2368x1568; color fundus photograph
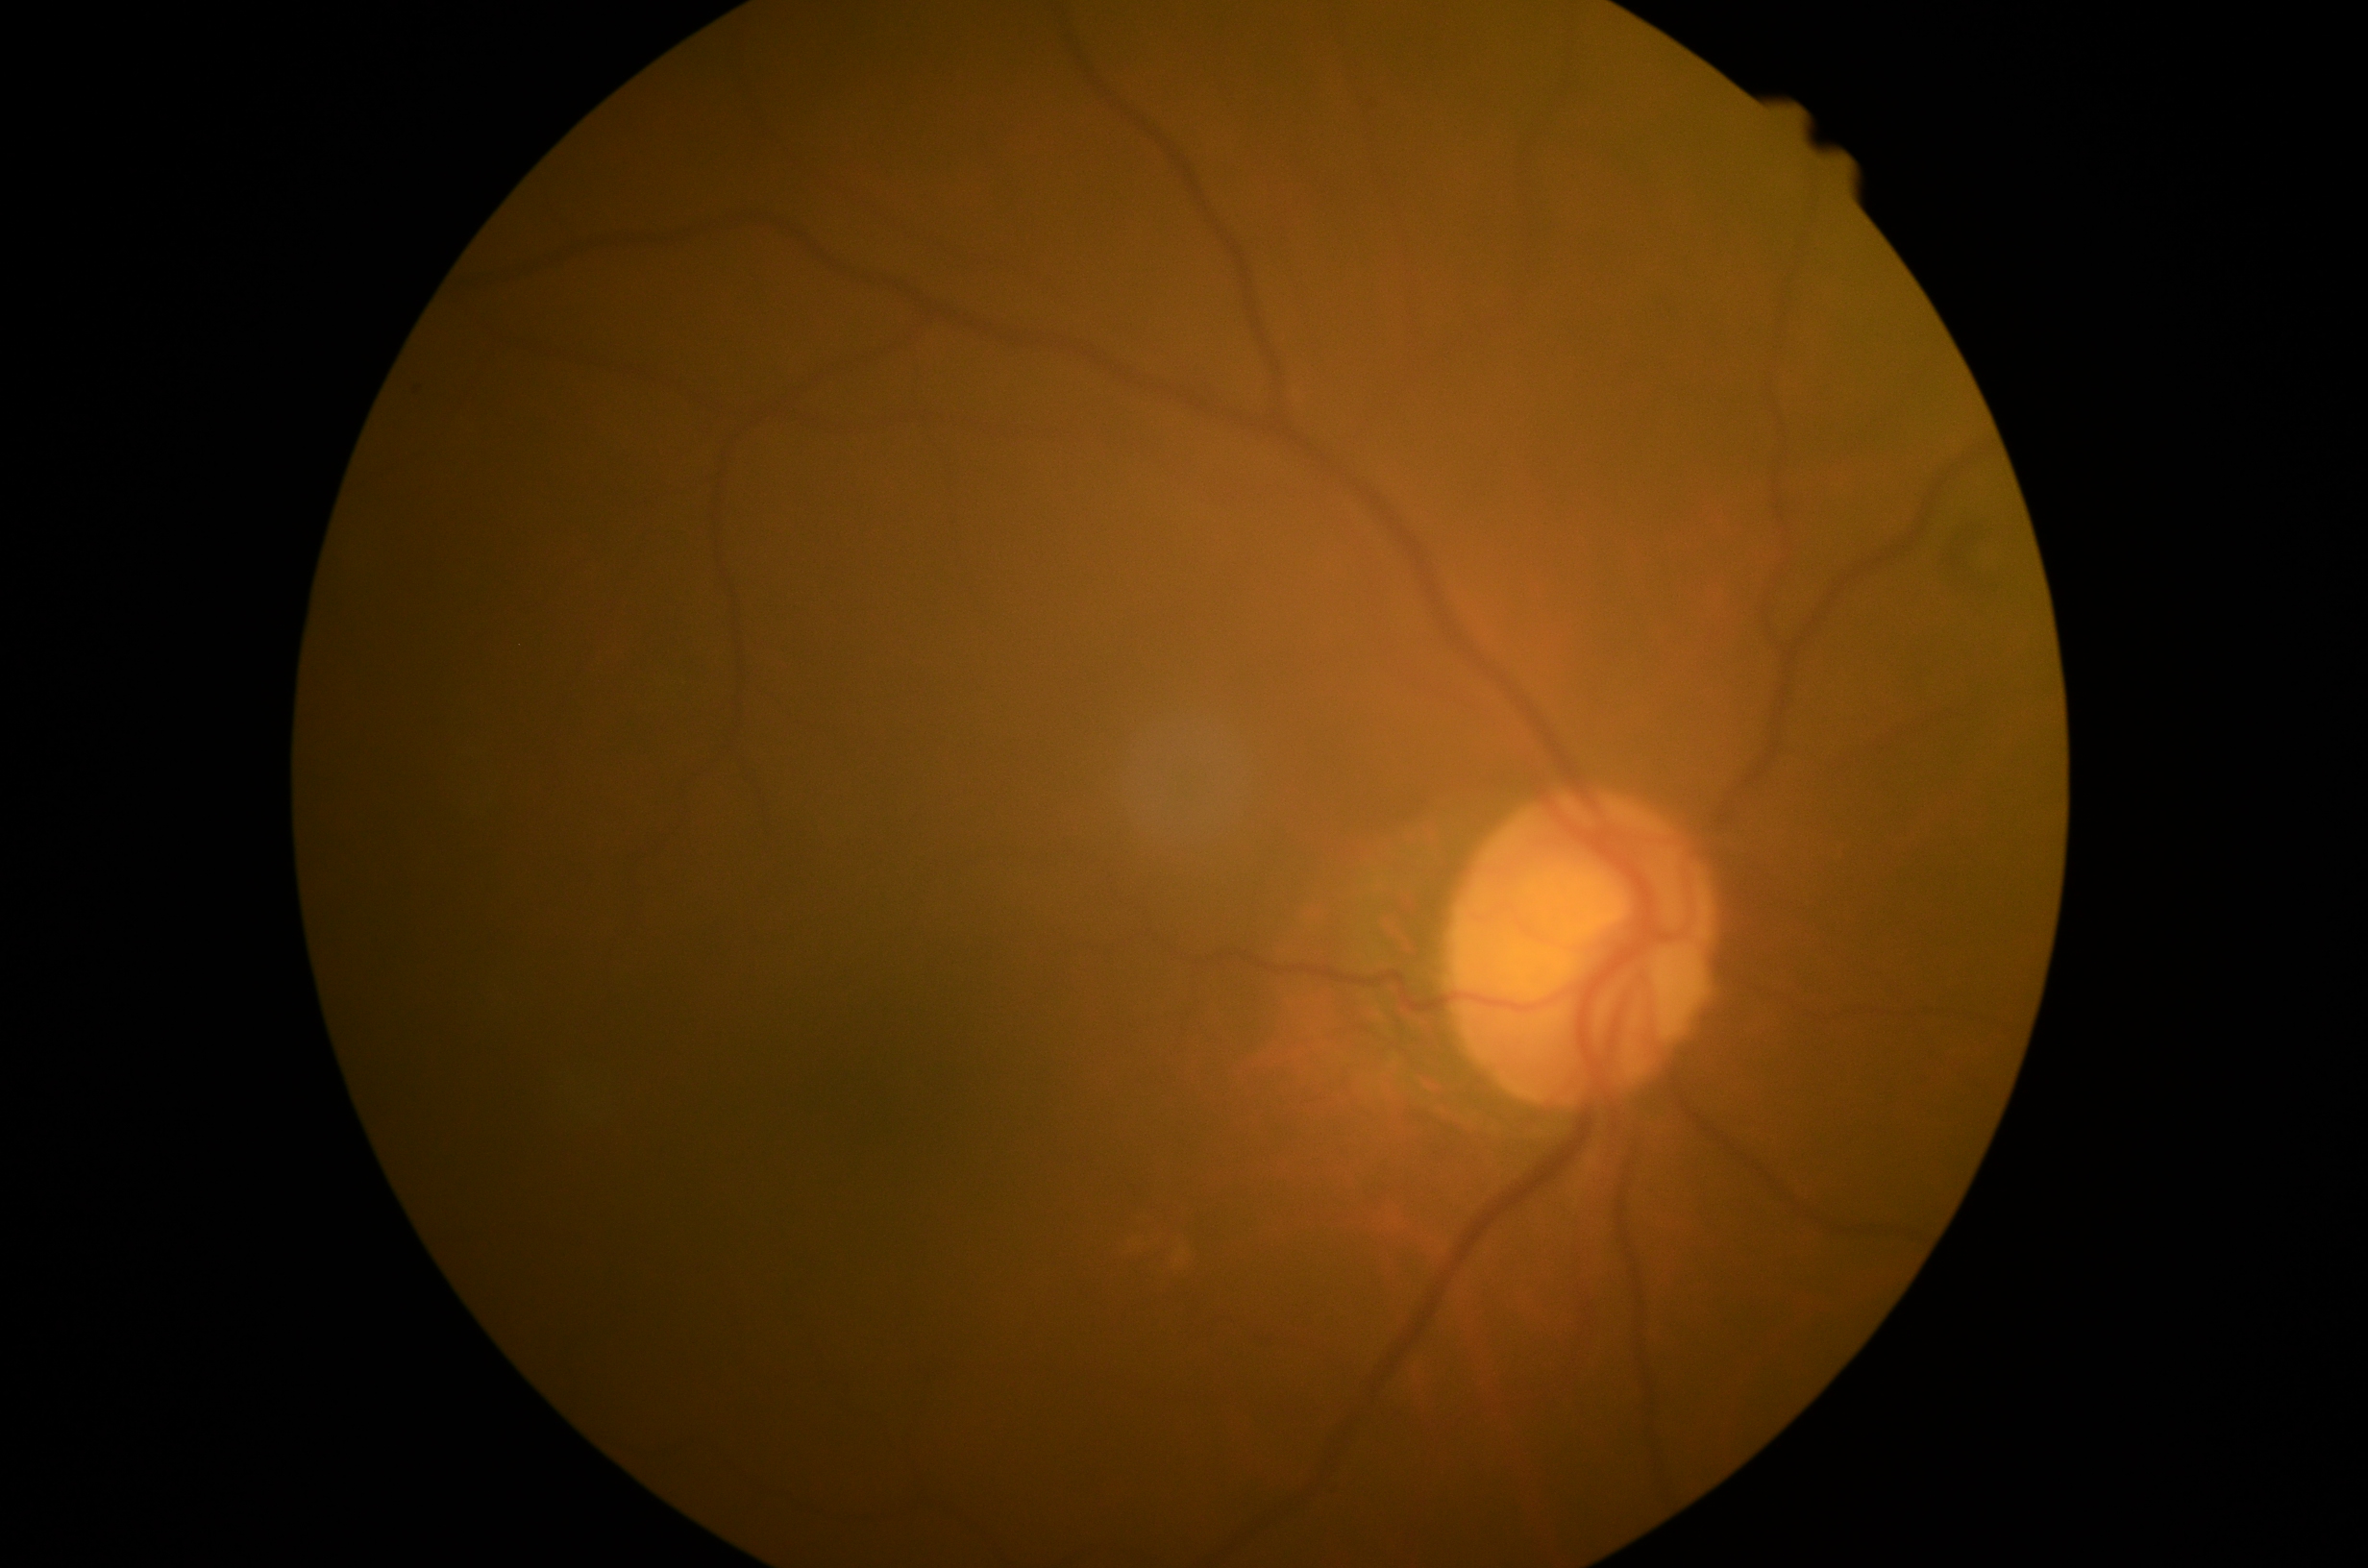
– DR — 2/4